FOV: 45 degrees · posterior pole color fundus photograph · camera: NIDEK AFC-230 · 848 by 848 pixels · diabetic retinopathy graded by the modified Davis classification
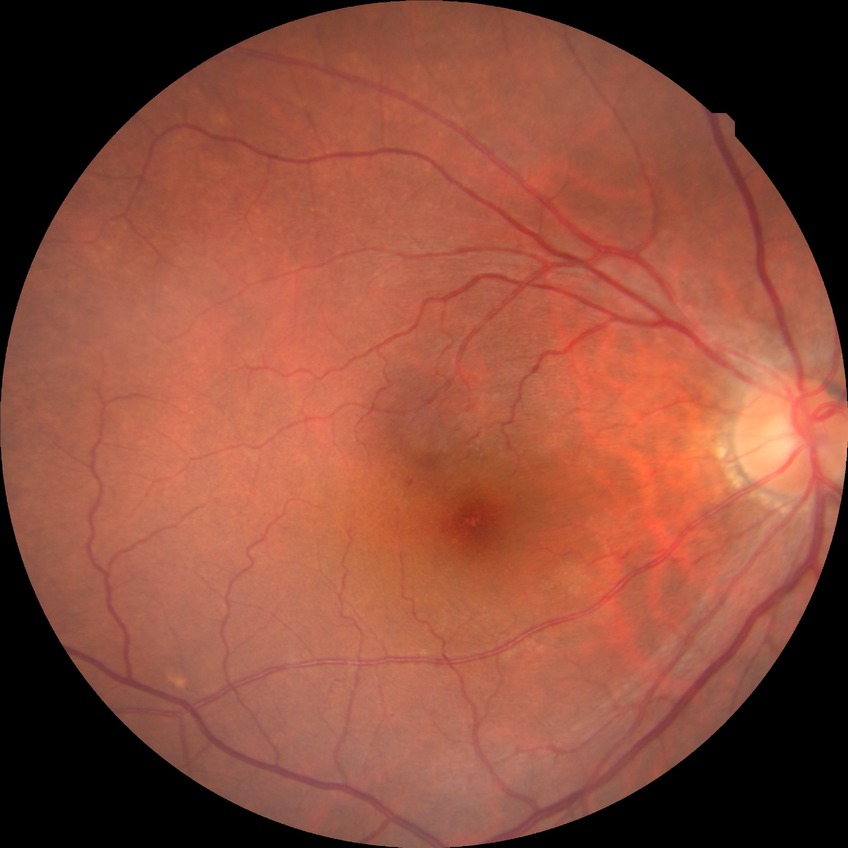
diabetic retinopathy (DR) = NDR (no diabetic retinopathy).